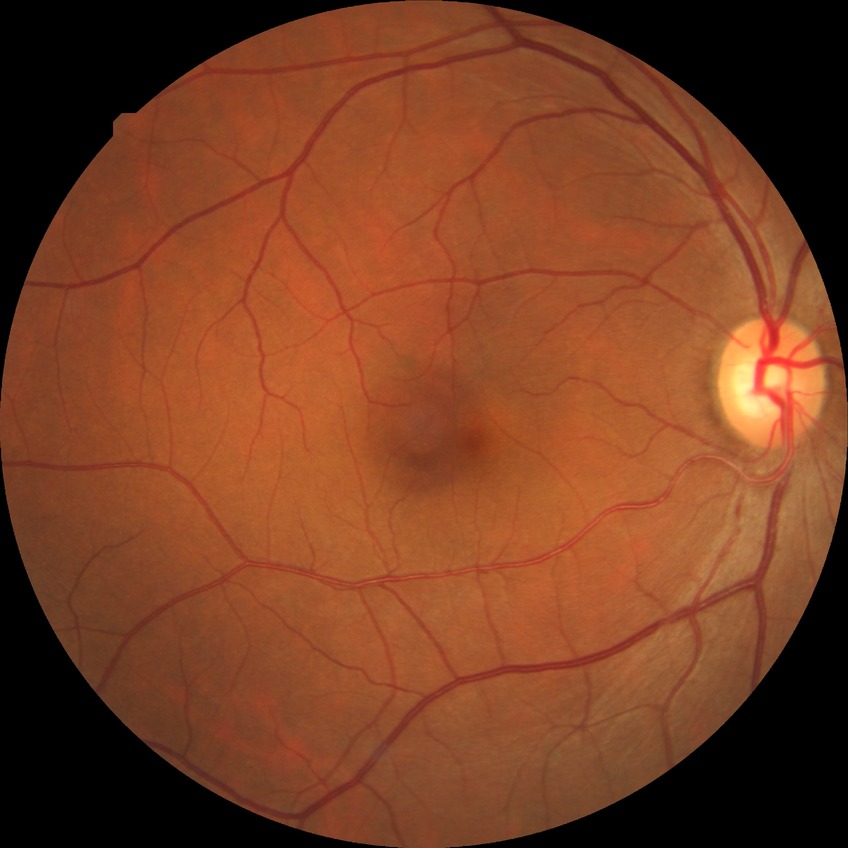 Diabetic retinopathy stage: no diabetic retinopathy.